100° field of view (Phoenix ICON). Wide-field contact fundus photograph of an infant. Image size 1240x1240:
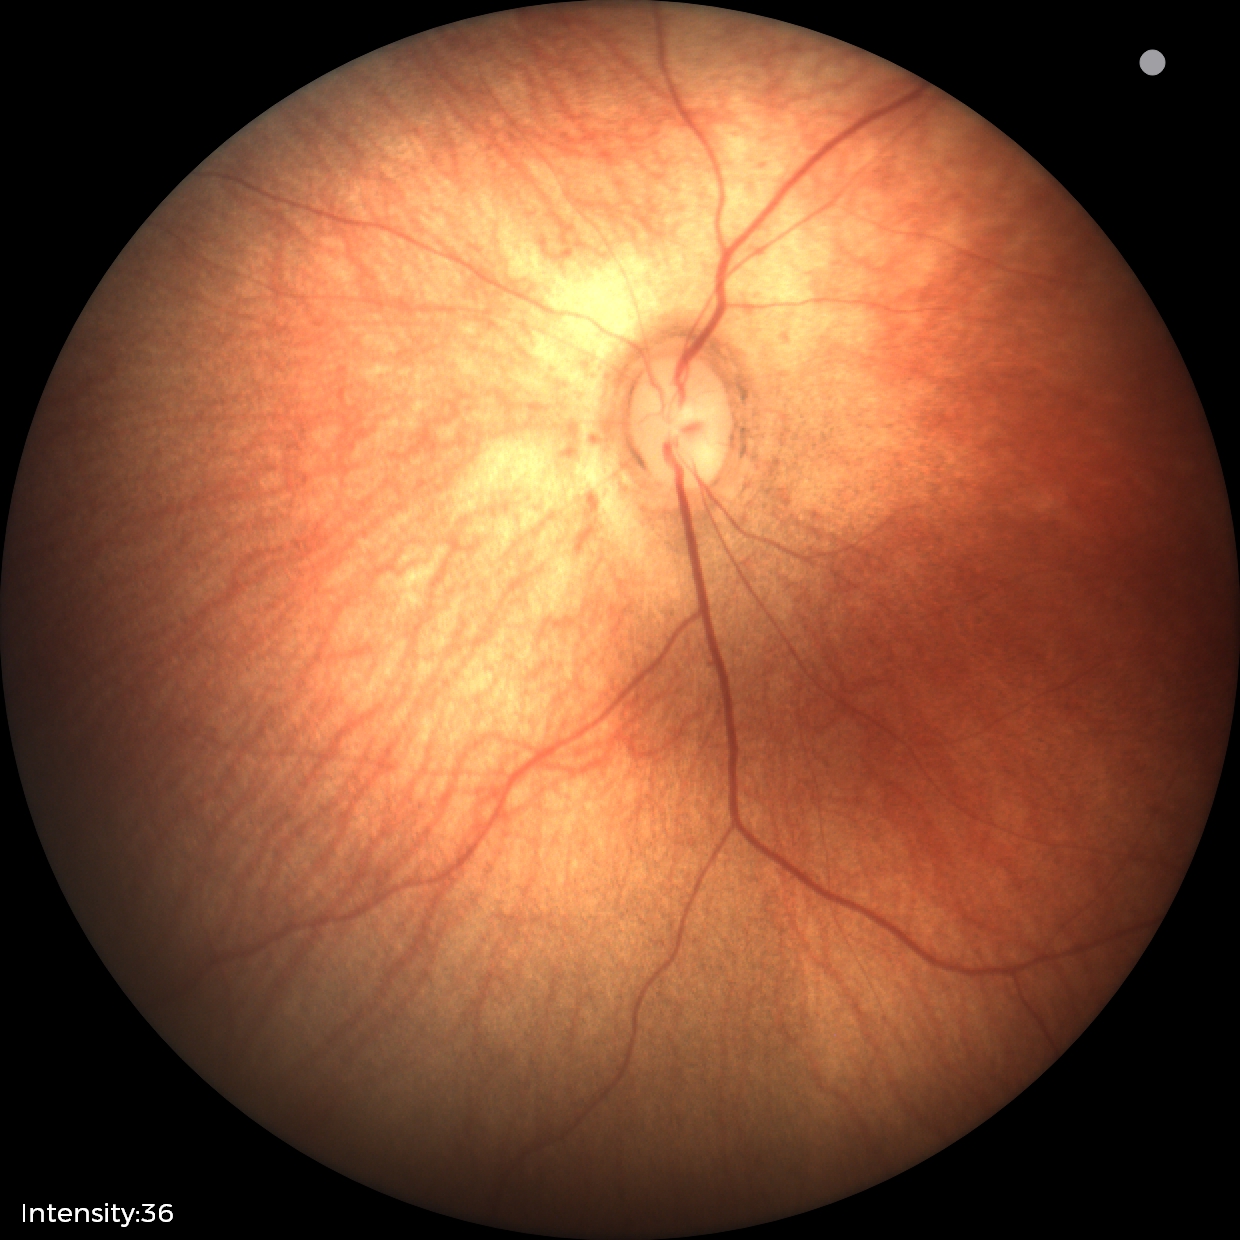

Screening examination diagnosed as physiological.